Diabetic retinopathy graded by the modified Davis classification: 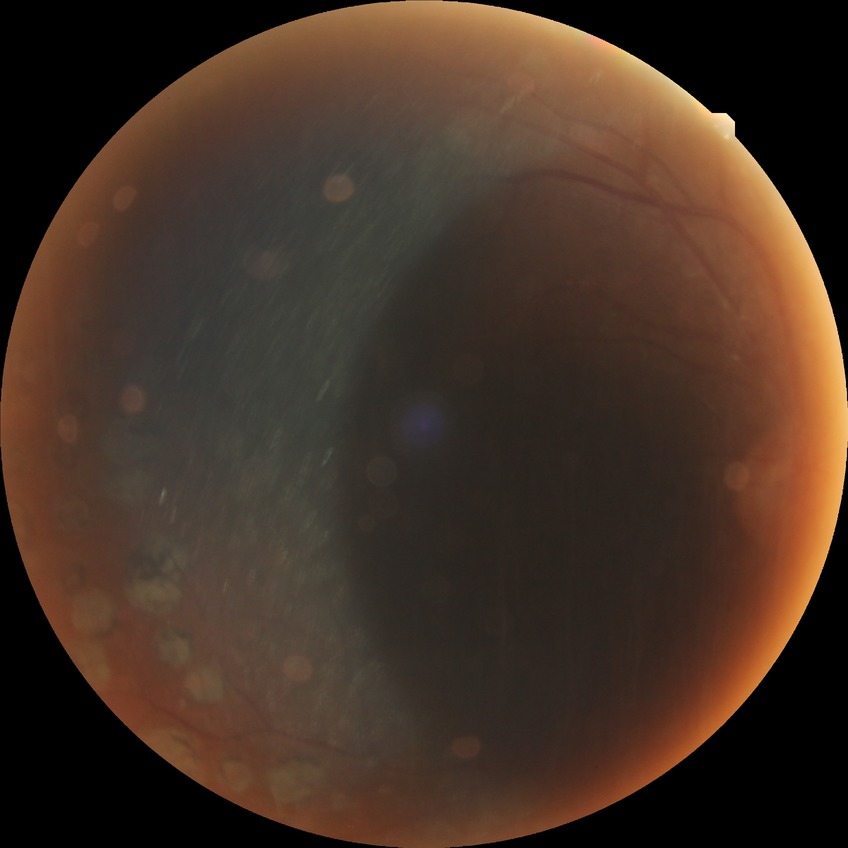

diabetic retinopathy (DR) = PDR (proliferative diabetic retinopathy).